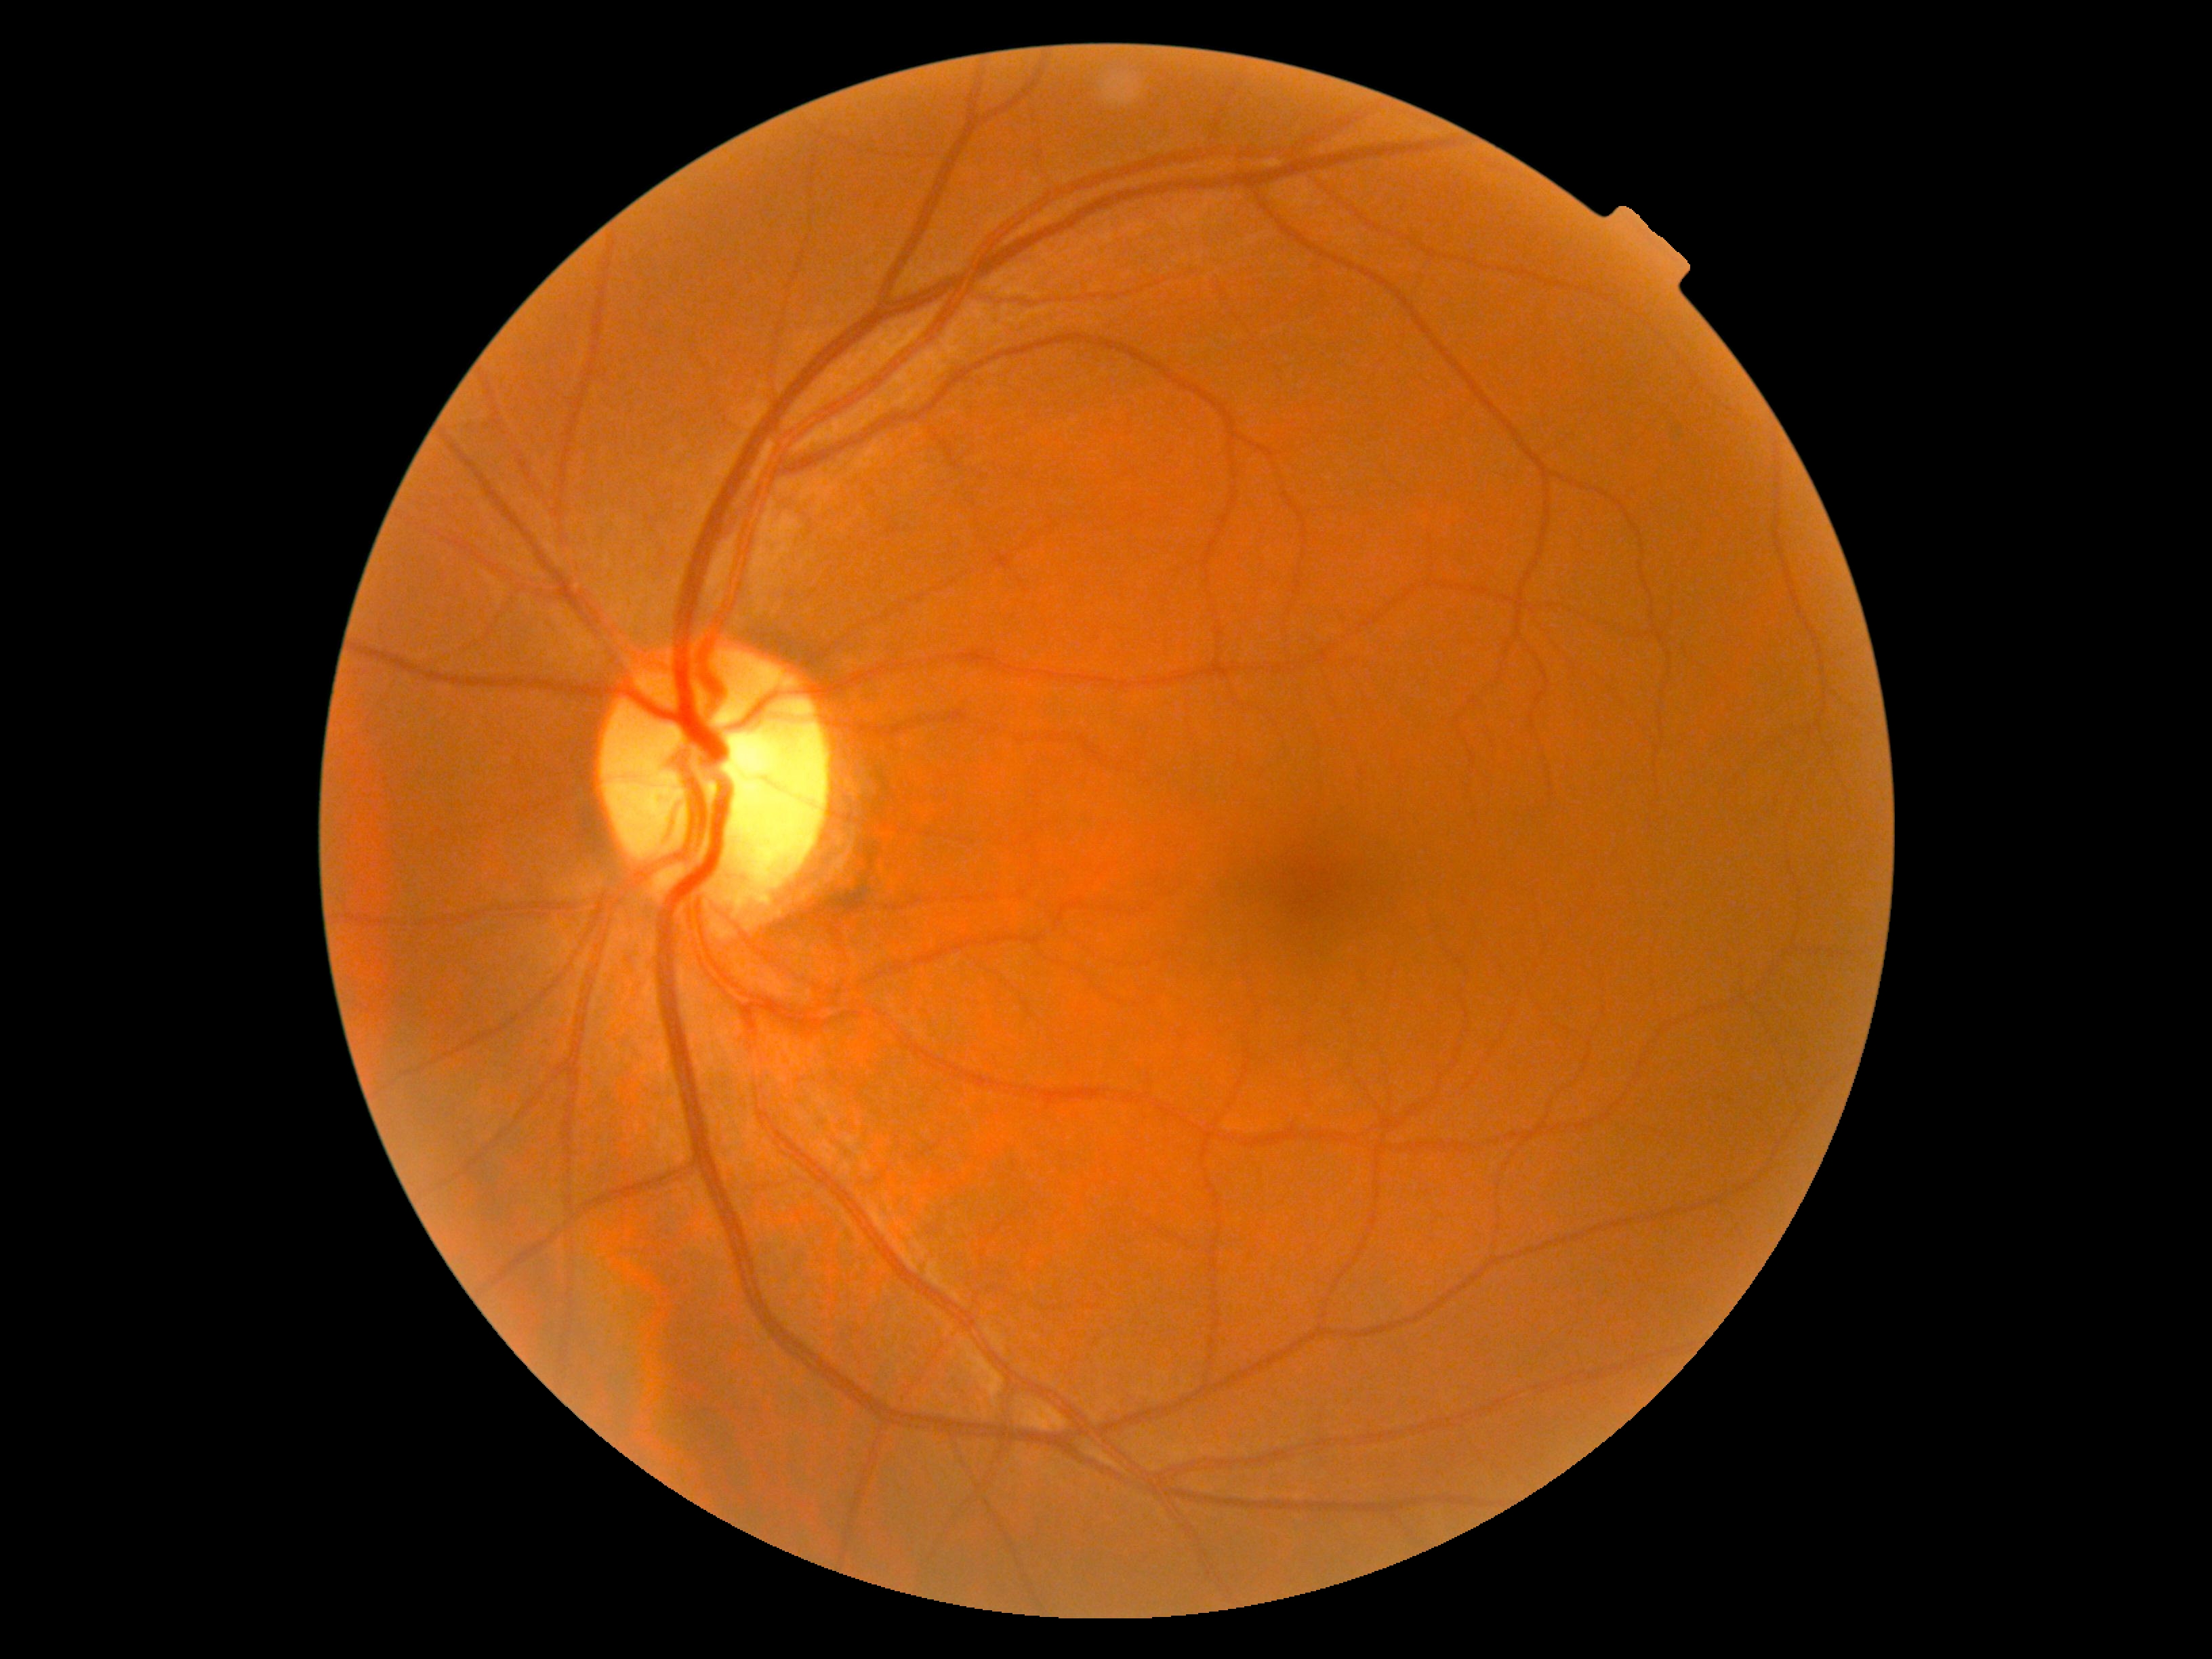 No diabetic retinal disease findings.
DR grade is 0 (no apparent retinopathy).